Retinal fundus photograph — 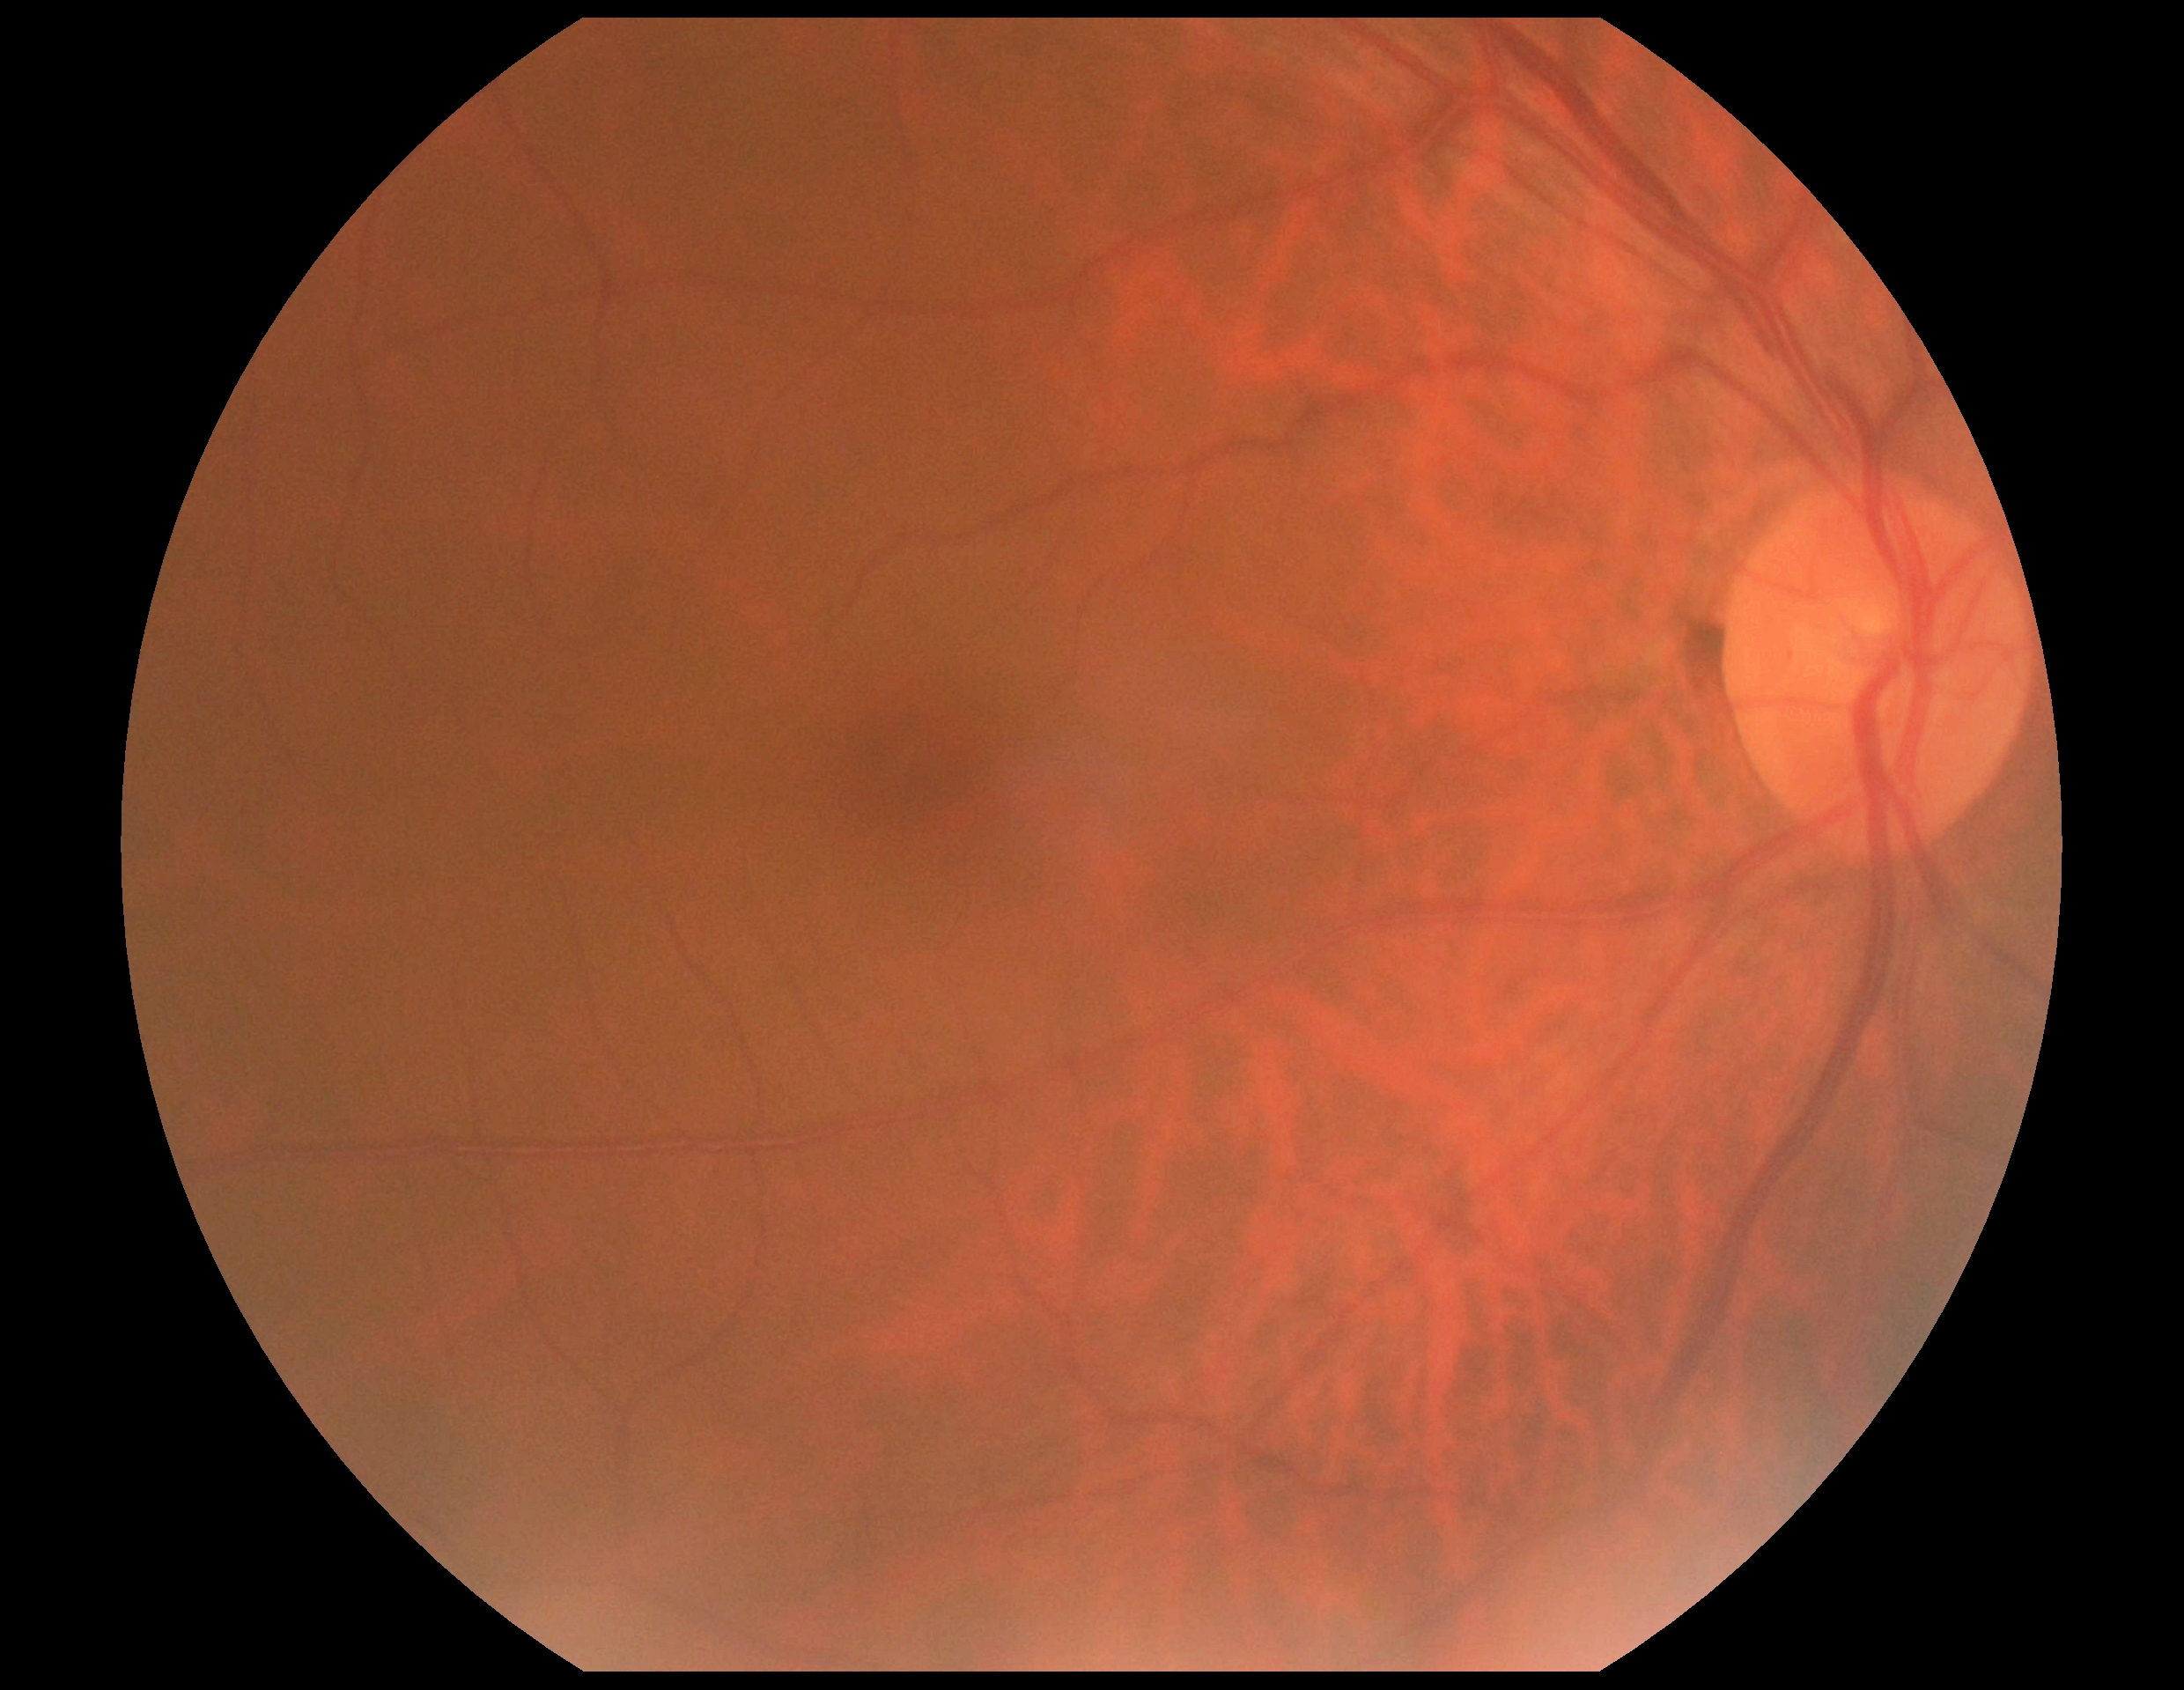 diabetic retinopathy (DR) = 0.